Camera: Nidek AFC-330
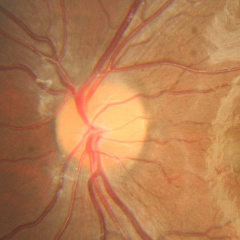

Q: Does this eye have glaucoma?
A: No glaucoma.